Fundus photo
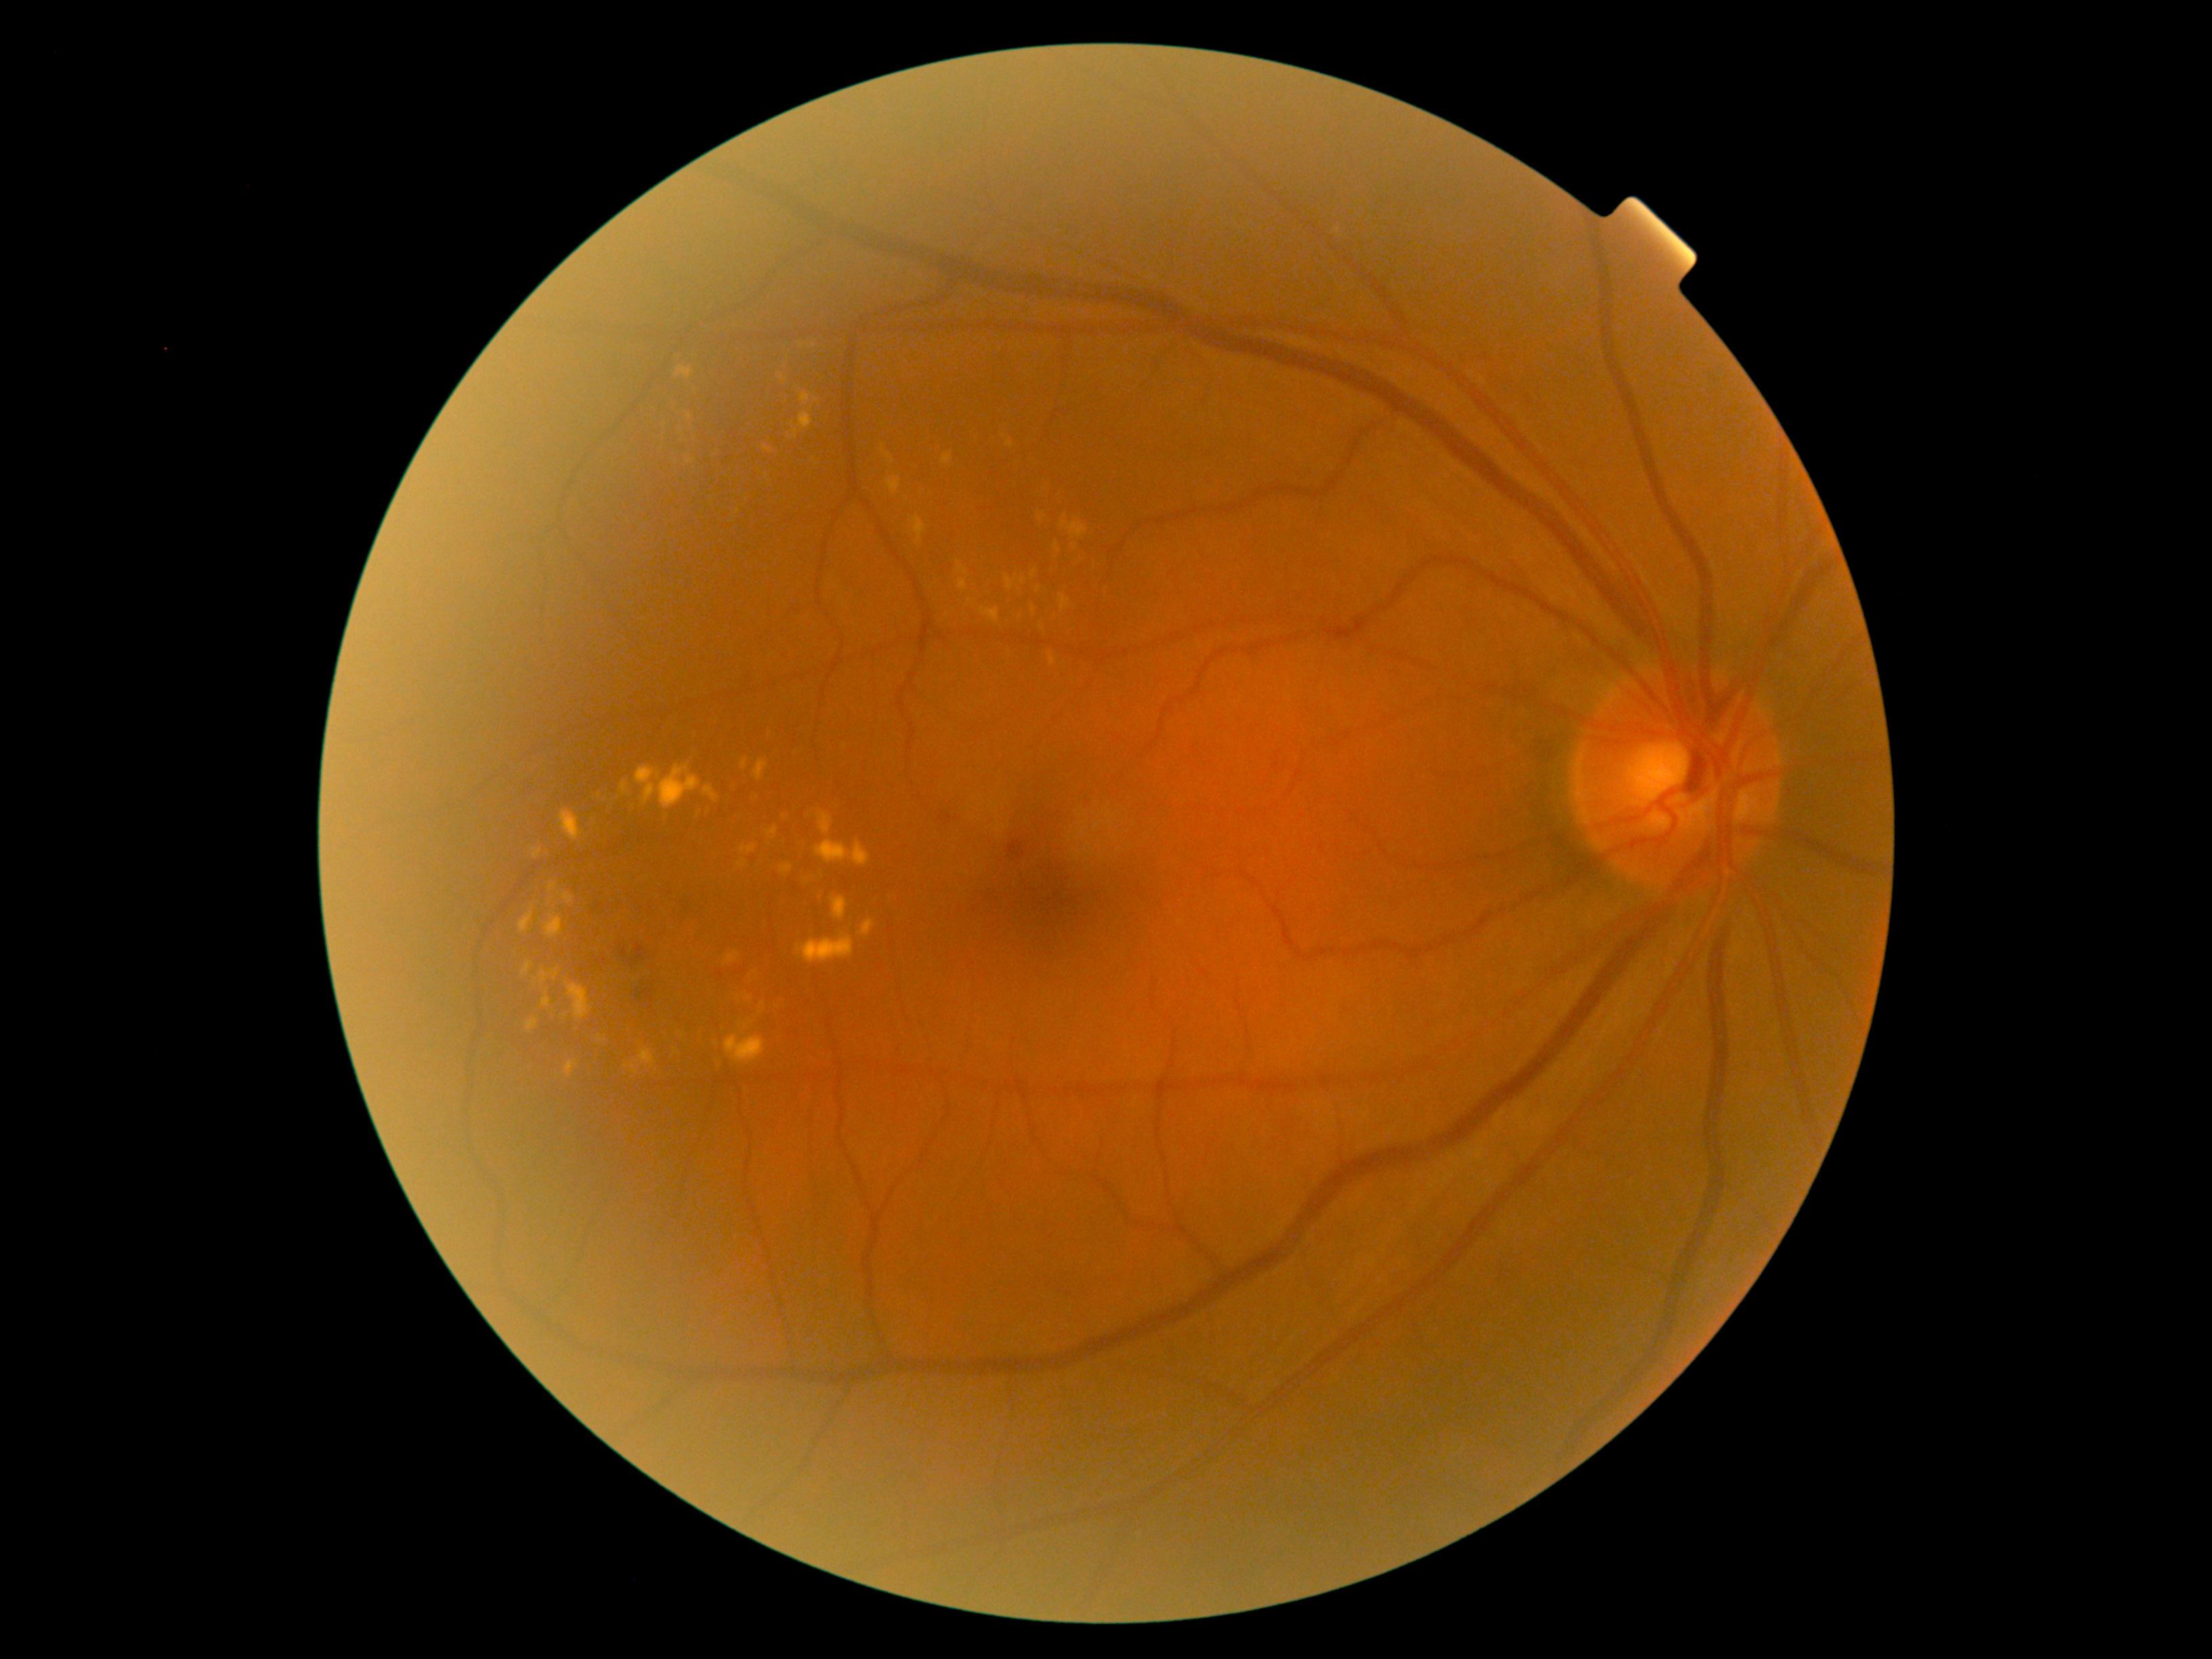 Diabetic retinopathy (DR): 2/4
Selected lesions:
• hemorrhages (HEs): <region>677, 893, 688, 914</region>; <region>642, 989, 654, 1004</region>; <region>598, 895, 608, 916</region>; <region>631, 943, 646, 963</region>; <region>1005, 841, 1025, 860</region>; <region>939, 814, 955, 826</region>
• Small HEs near (624,952)
• hard exudates (EXs) (partial): <region>550, 882, 558, 893</region>; <region>791, 424, 799, 437</region>; <region>635, 764, 701, 808</region>; <region>593, 791, 600, 799</region>; <region>639, 1050, 655, 1067</region>; <region>560, 893, 575, 906</region>; <region>912, 517, 926, 546</region>; <region>887, 476, 901, 495</region>; <region>1005, 577, 1013, 592</region>; <region>741, 844, 757, 853</region>; <region>567, 983, 593, 1020</region>; <region>523, 963, 533, 975</region>; <region>747, 960, 765, 978</region>; <region>630, 1063, 636, 1074</region>
• Small EXs near (761,1005); (601,1040); (846,747); (552,900); (1011,445); (1041,628)
• soft exudates (SEs): none detected
• microaneurysms (MAs): none detected